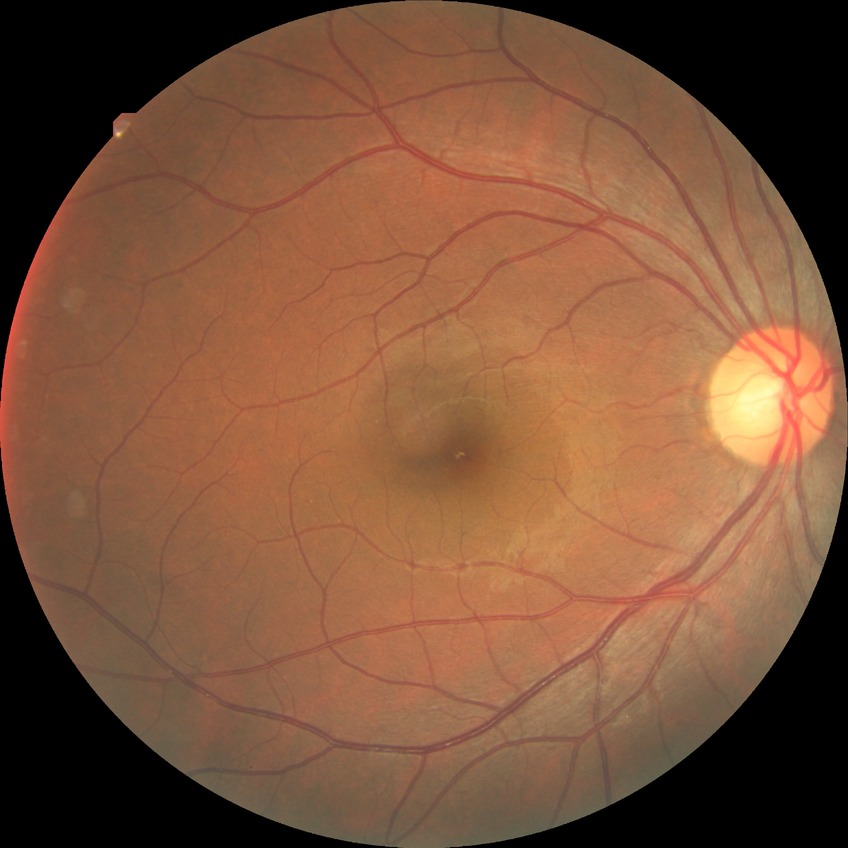

DR severity: NDR.